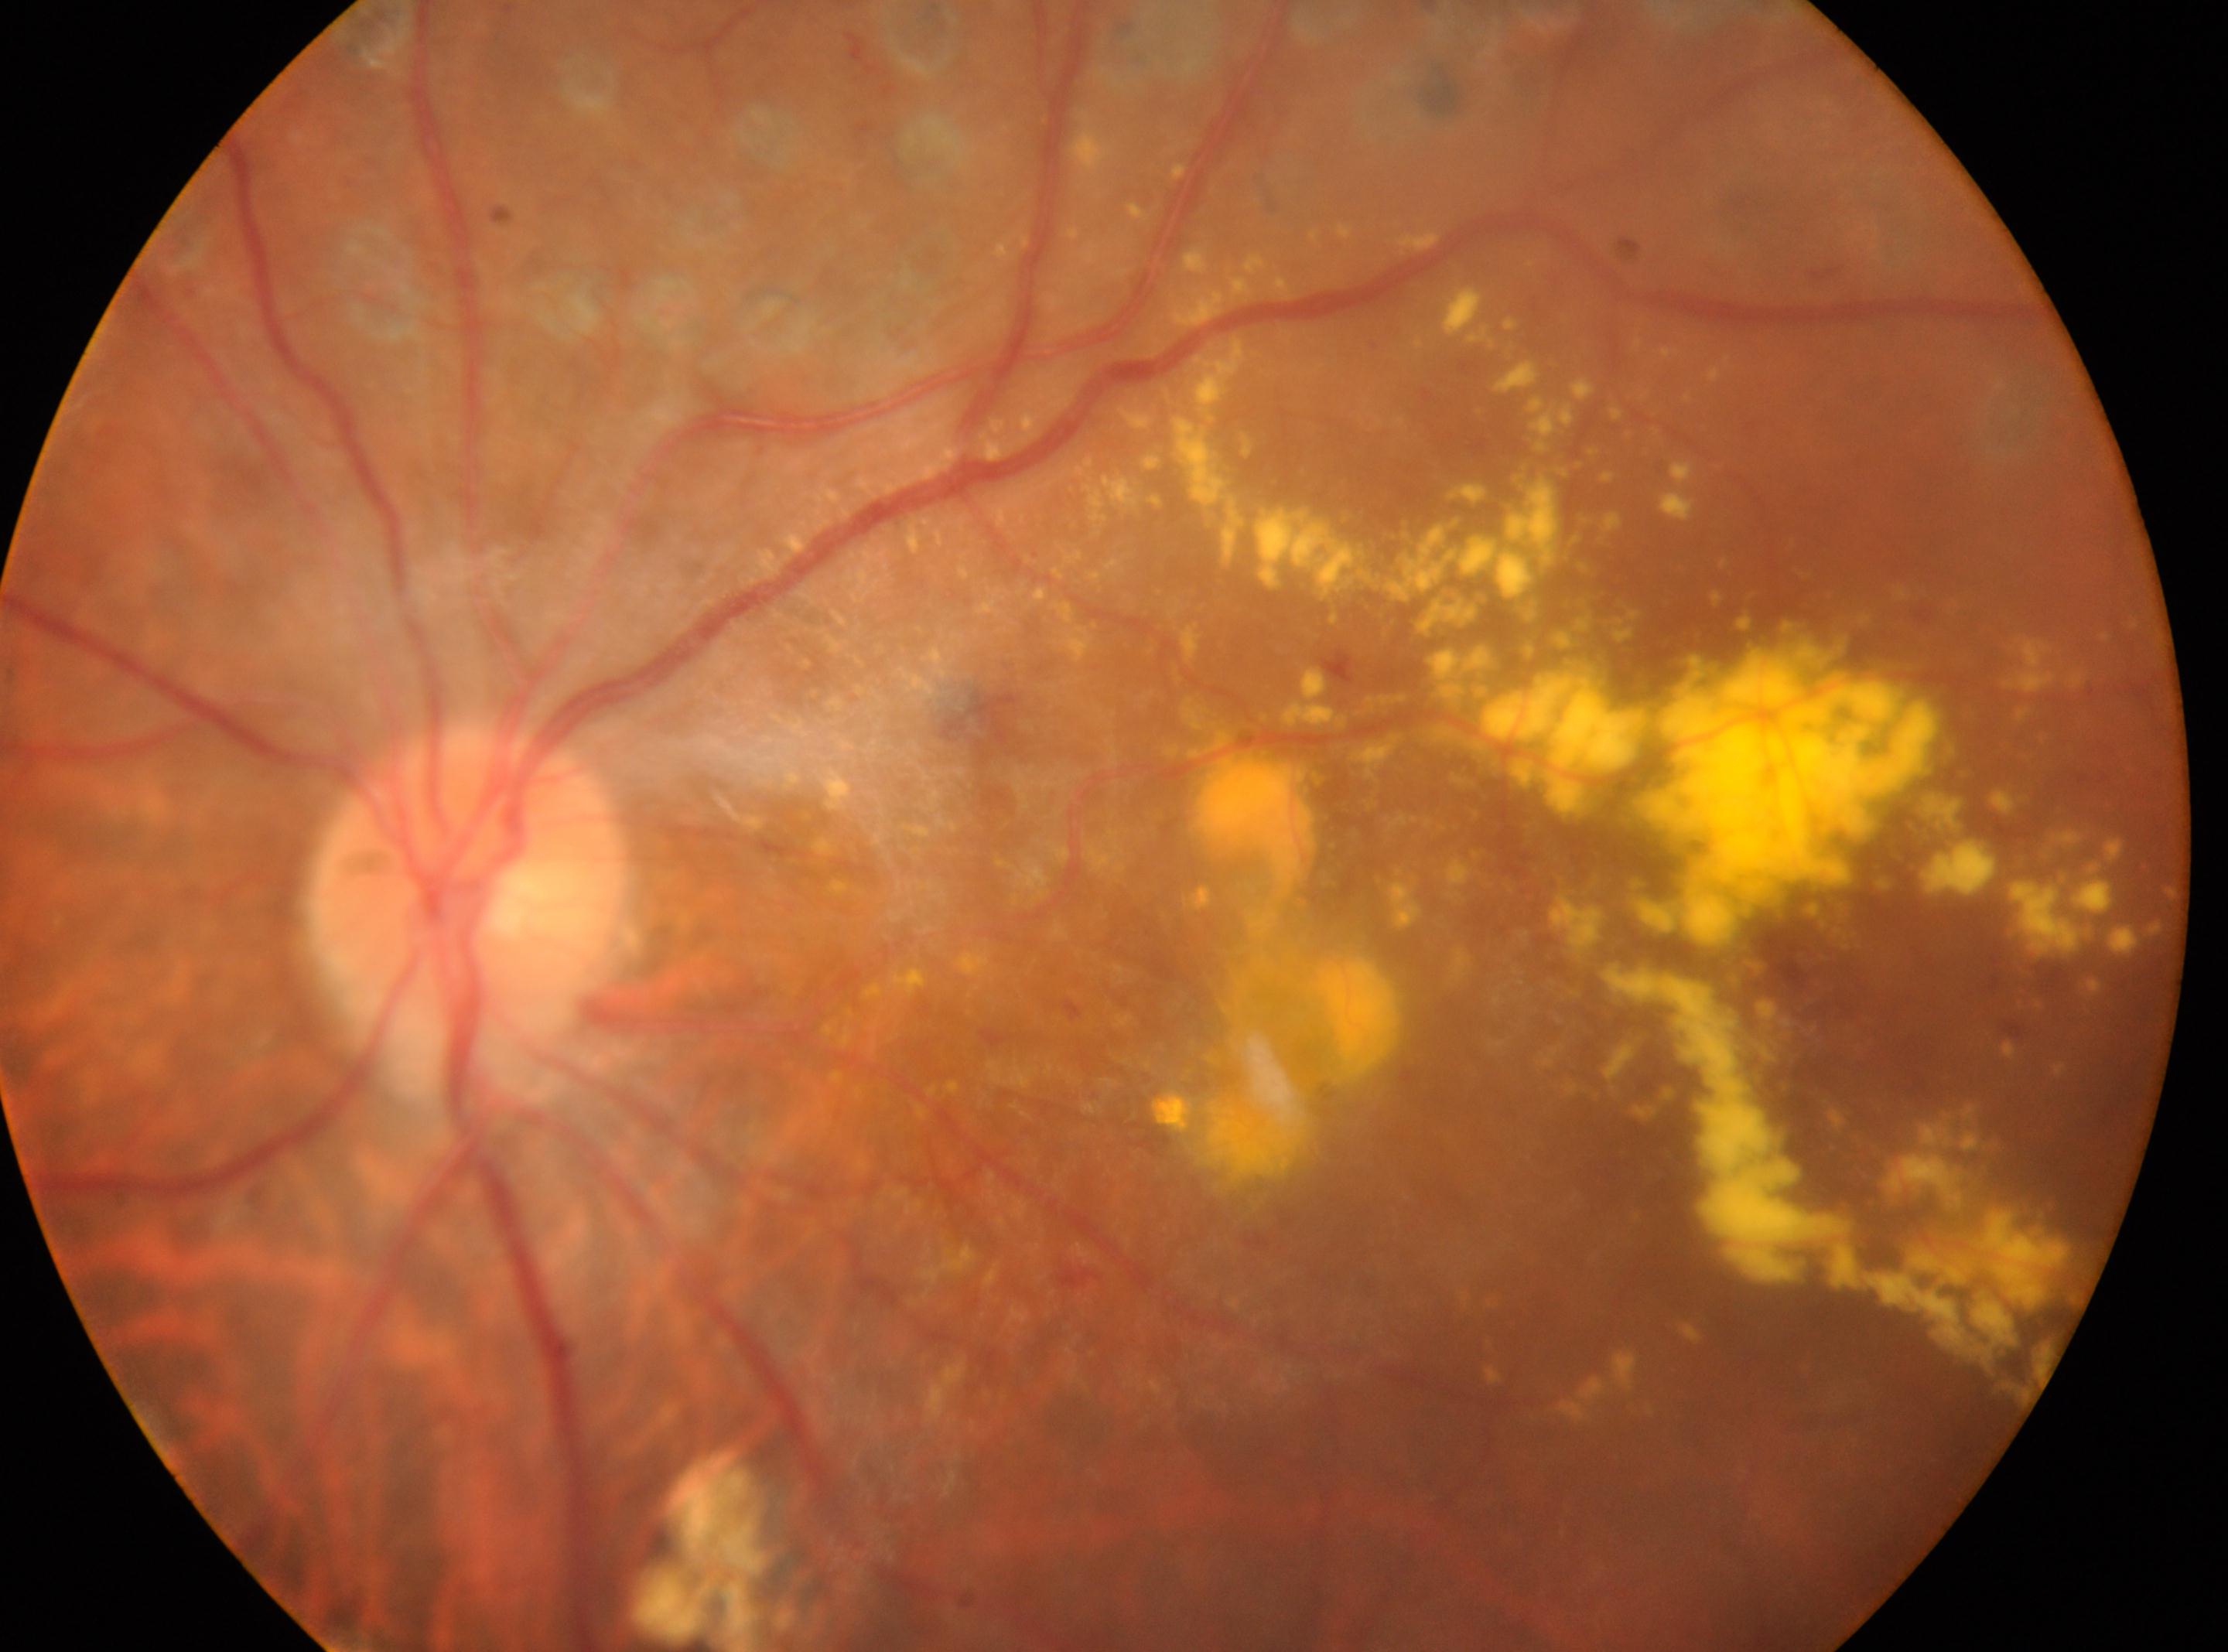

Q: What is the laterality?
A: OS
Q: Optic disc center?
A: 467, 910
Q: Diabetic retinopathy severity?
A: DR with laser photocoagulation scars, underlying severity PDR (grade 4)
Q: Where is the fovea?
A: 1263, 1055